Ultra-widefield fundus photograph. 1924x1556px: 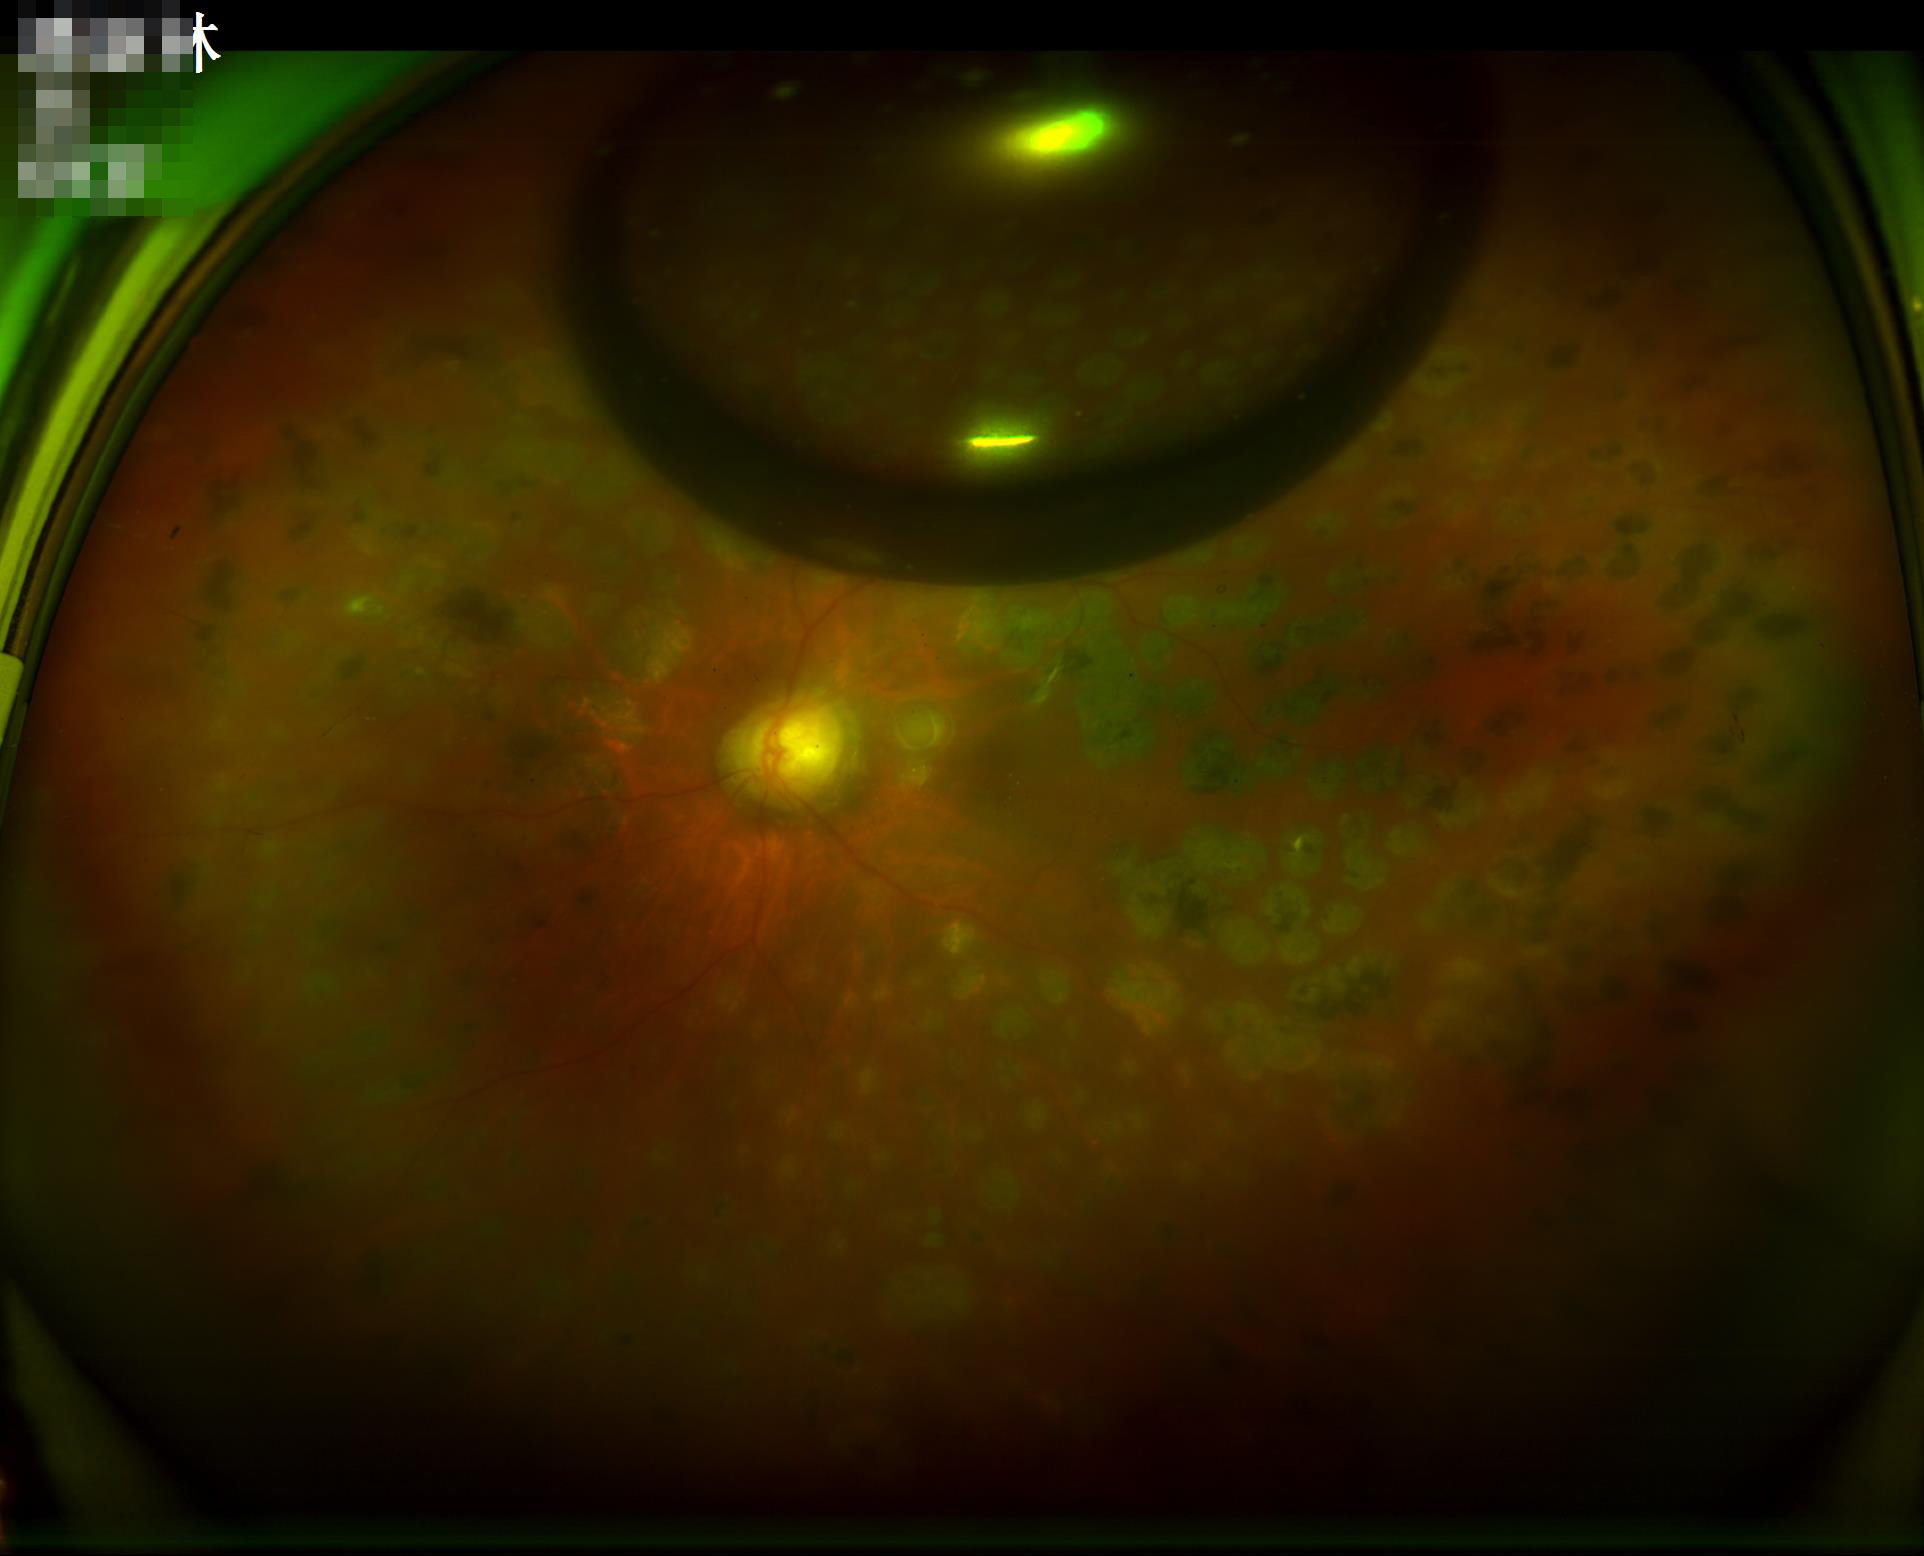 {"contrast": "adequate", "overall_quality": "poor", "illumination": "poor"}